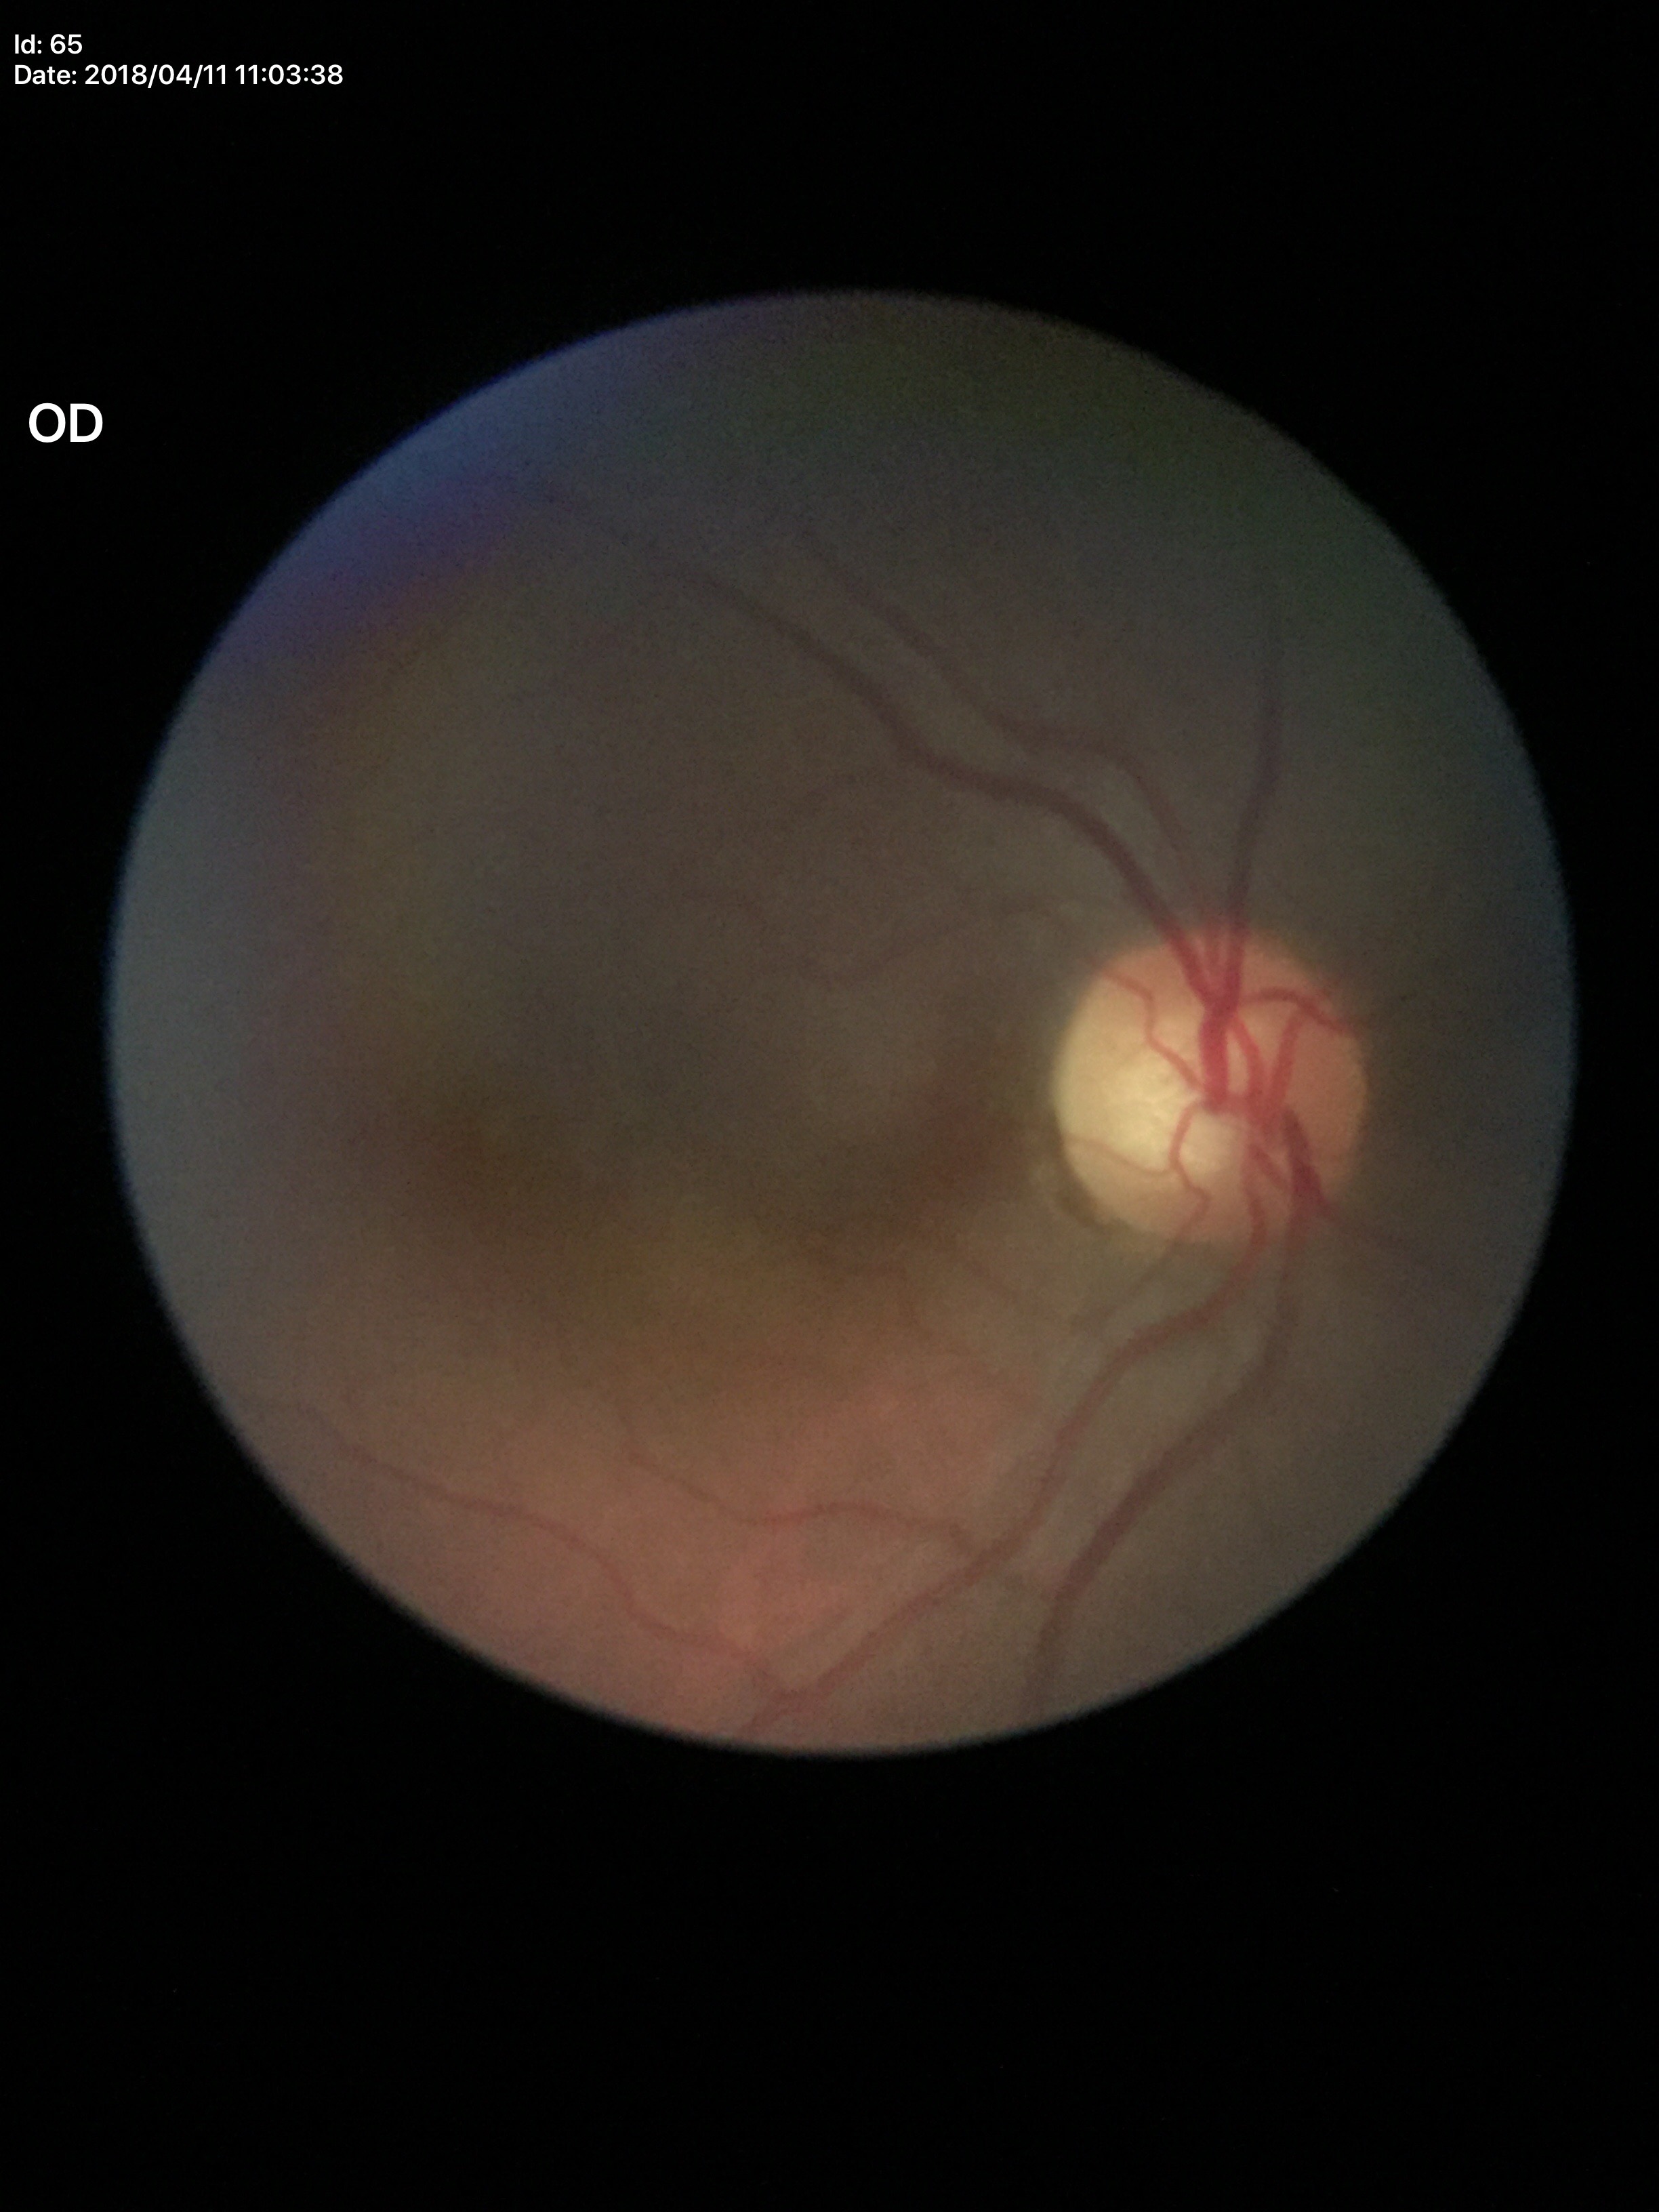

Glaucoma evaluation: suspicious. Vertical cup-to-disc ratio (VCDR) is 0.64.